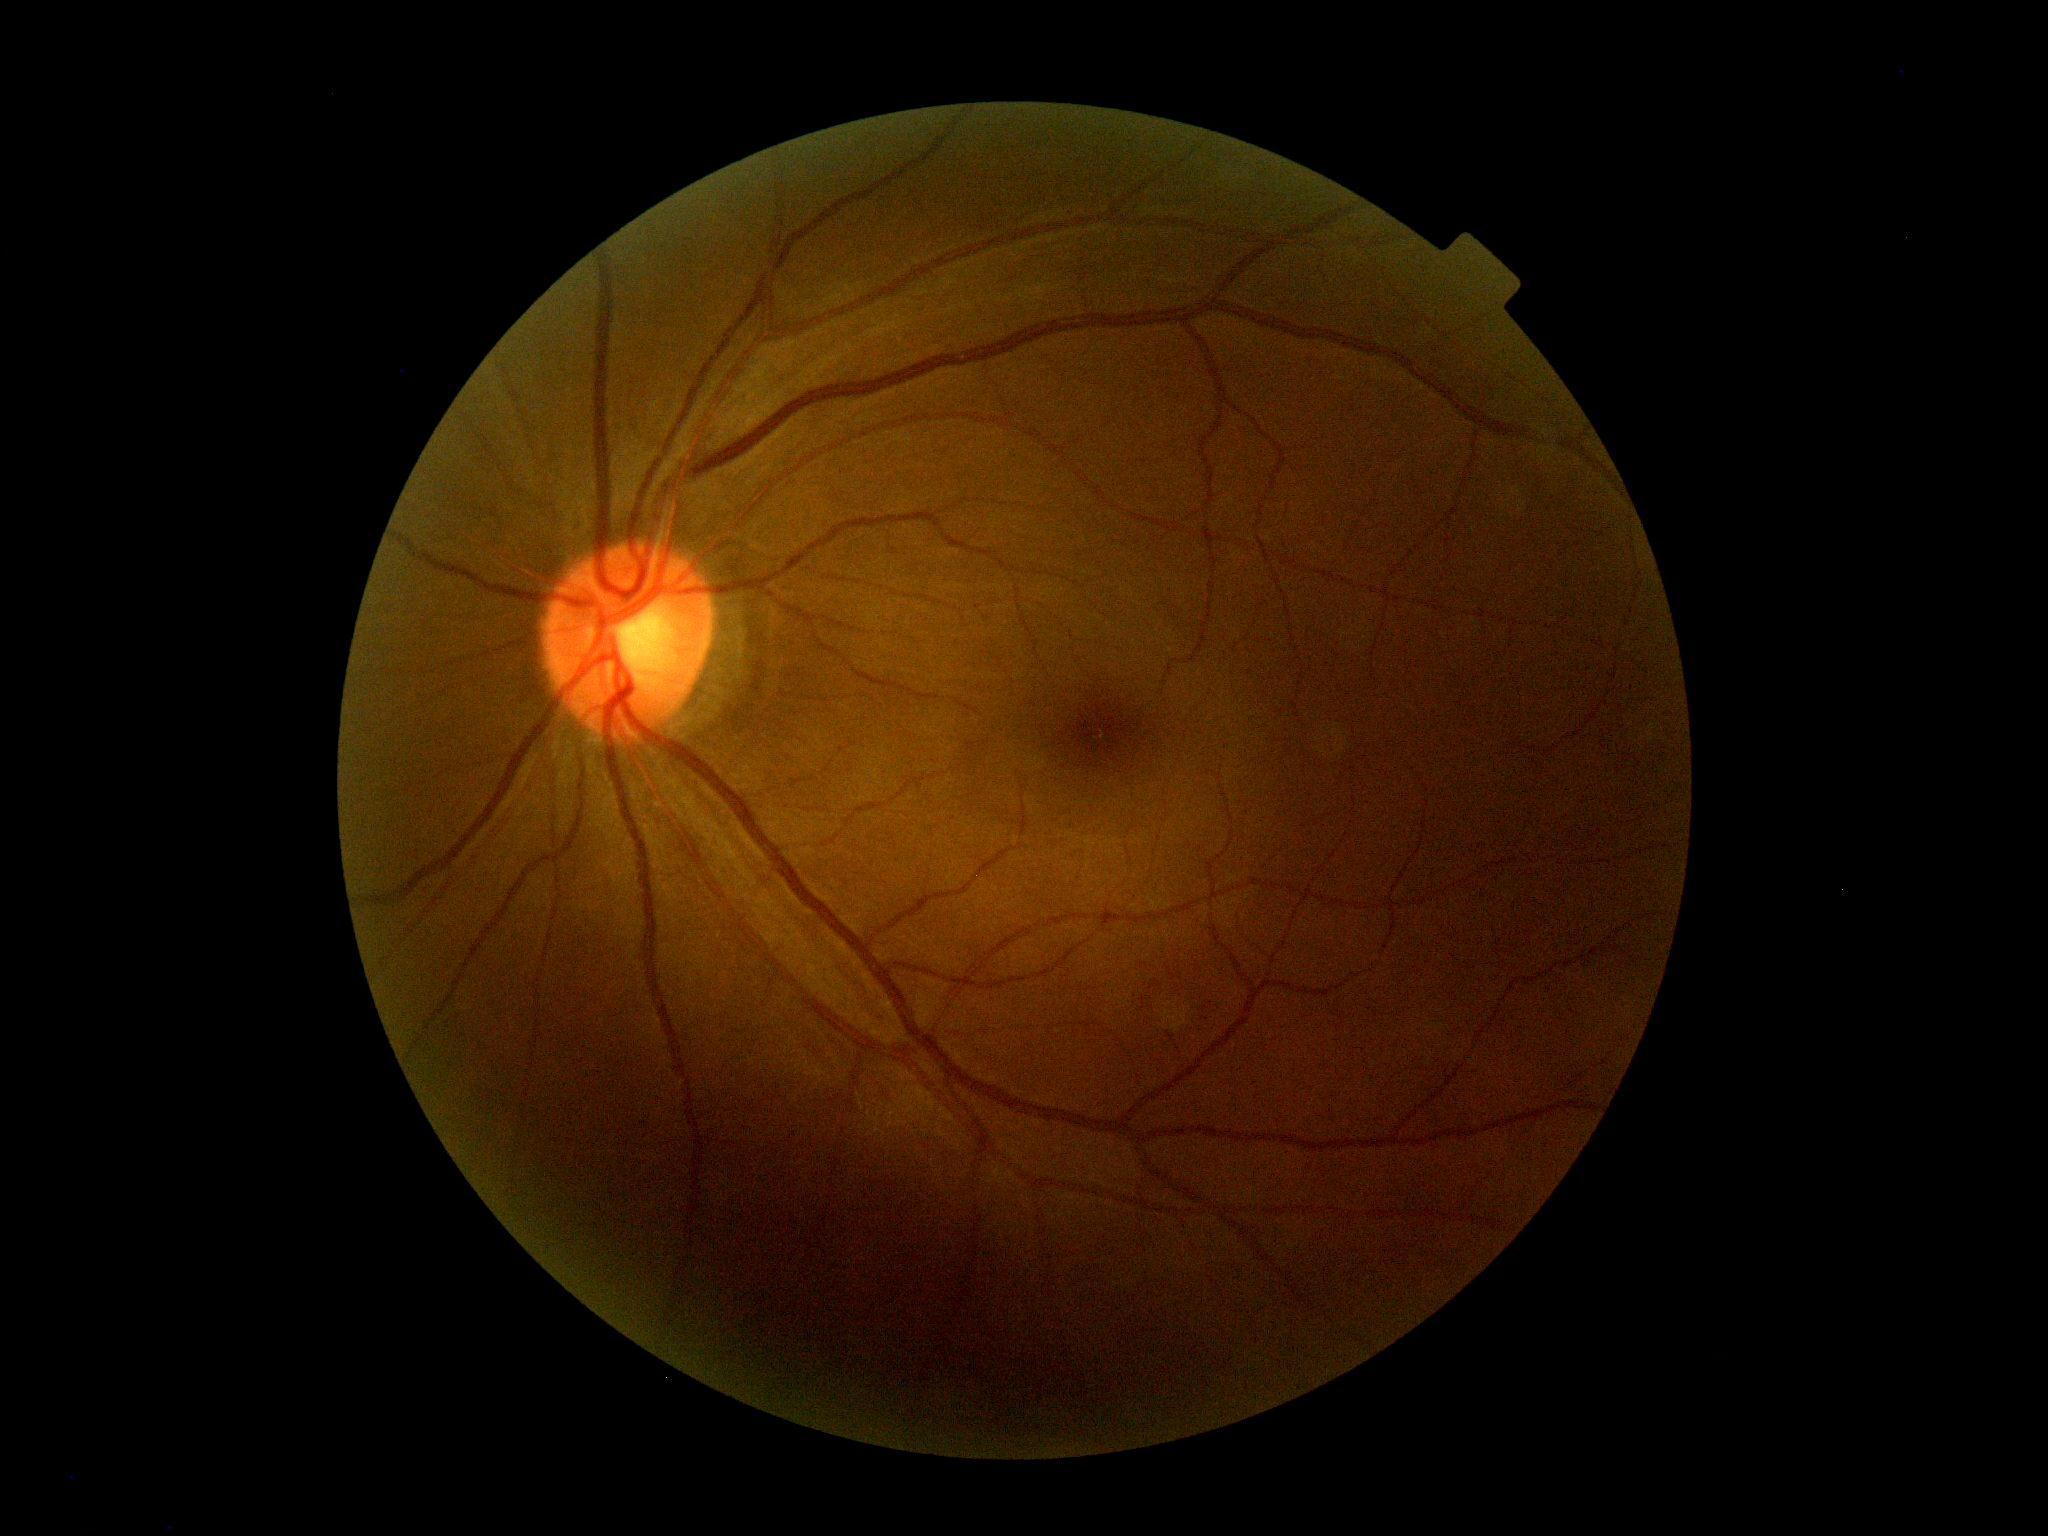 Findings:
- DR severity — grade 0